Retinal fundus photograph · 45° field of view — 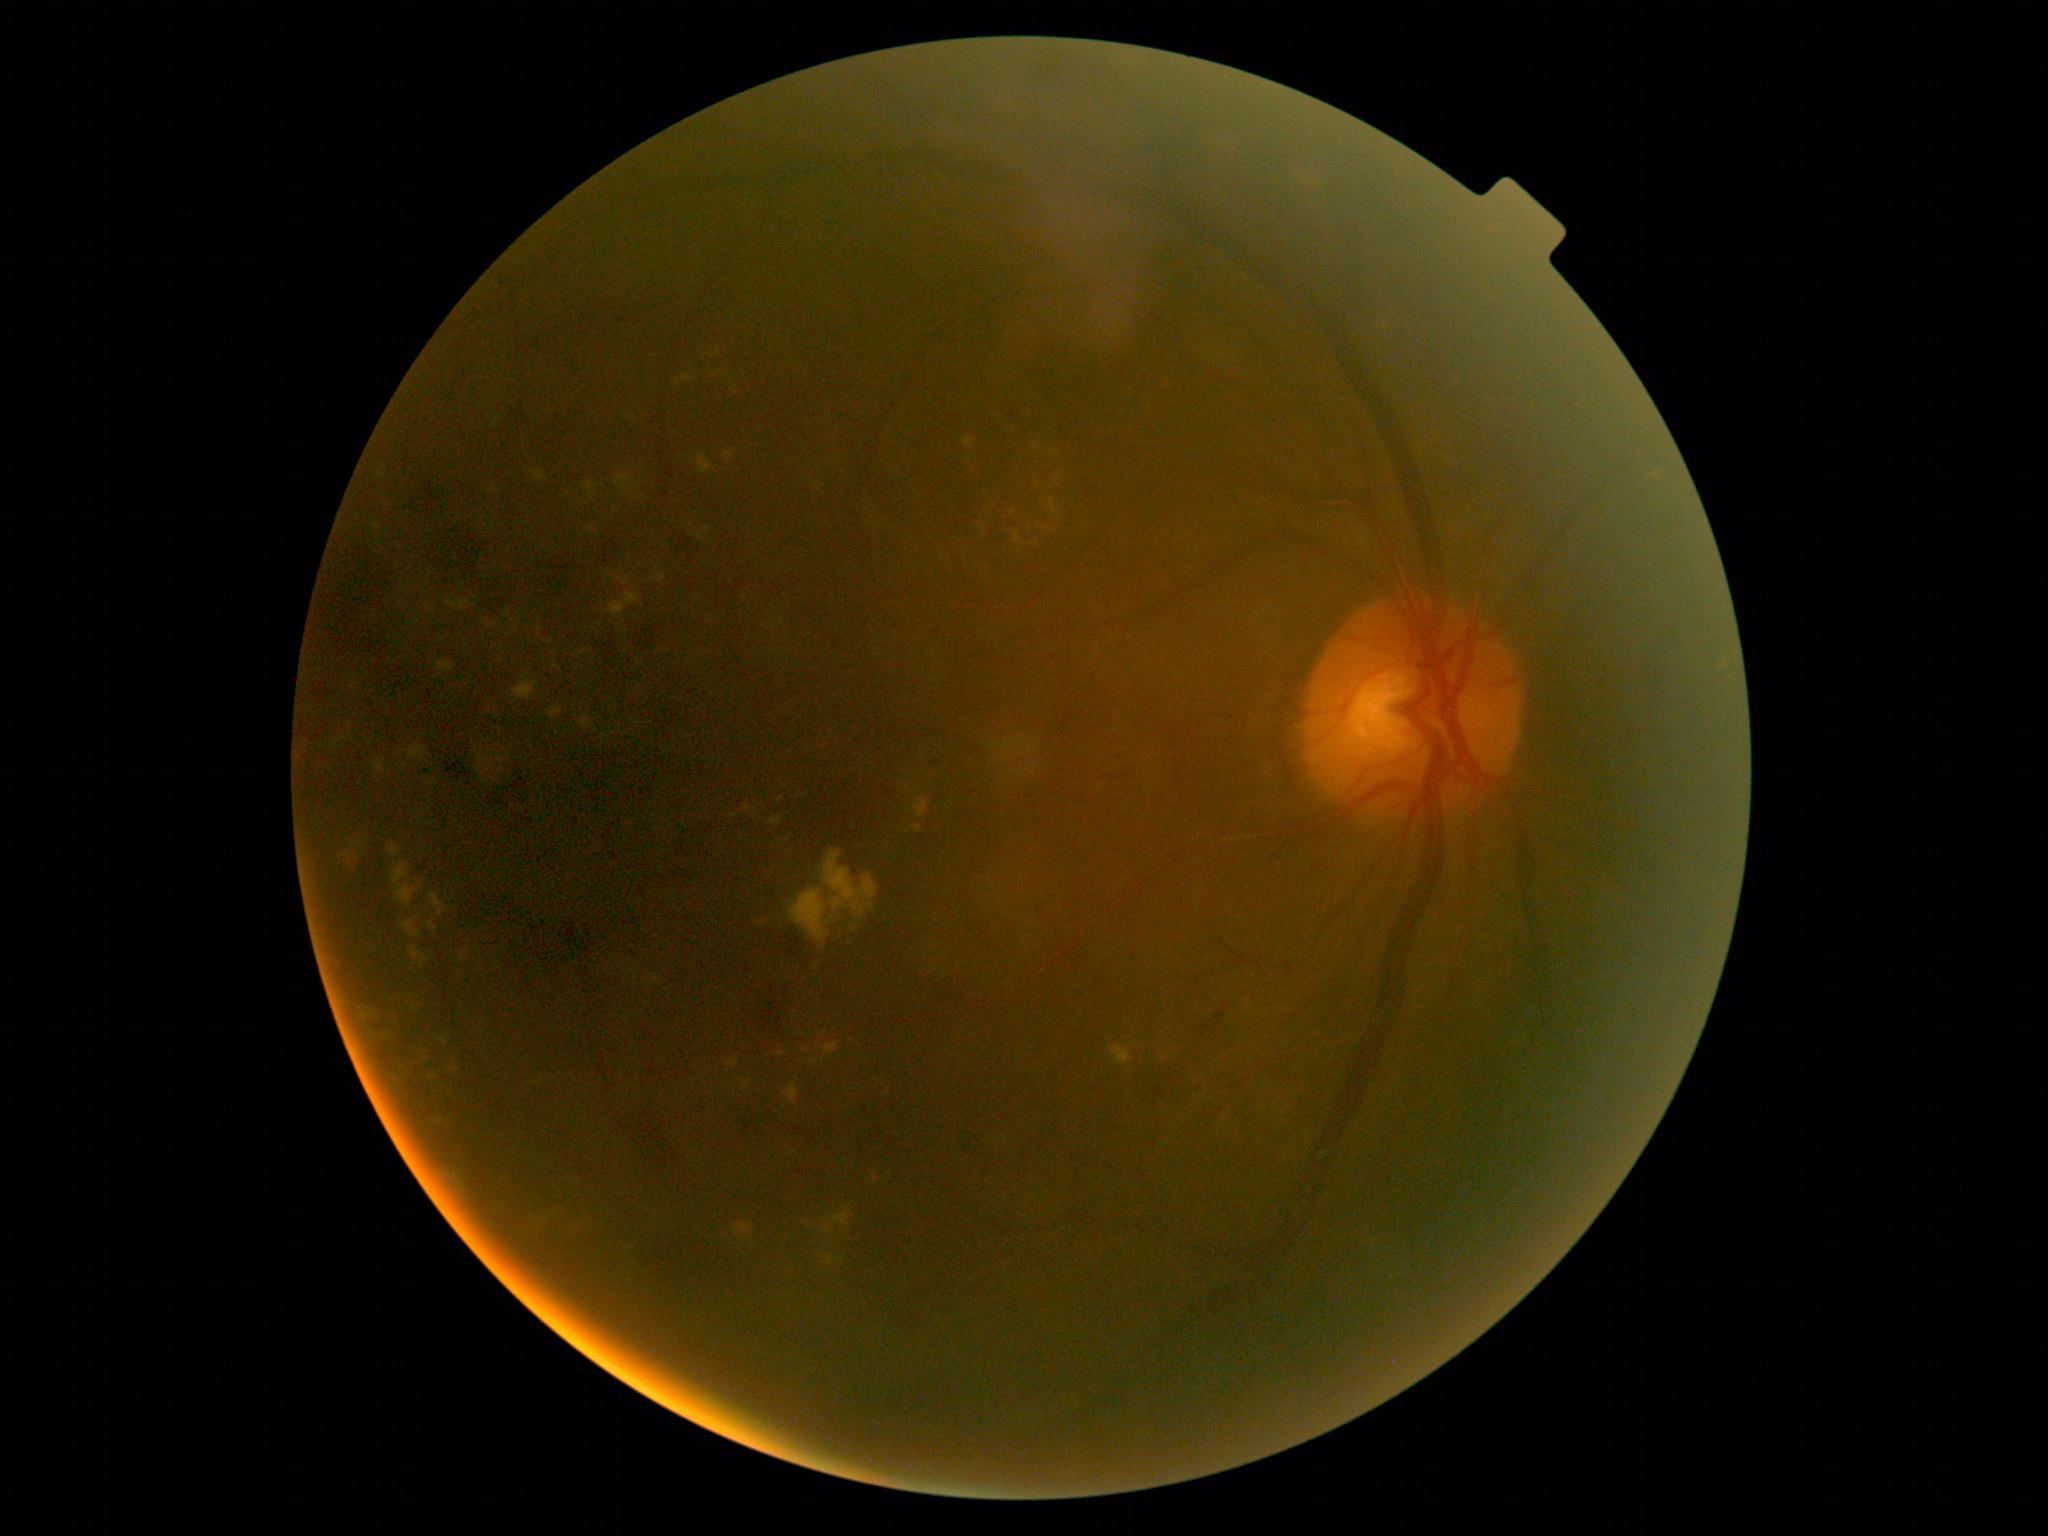

DR is grade 2 (moderate NPDR).